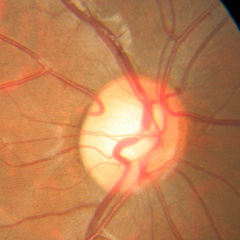

Glaucoma status = no evidence of glaucoma.